45-degree field of view — 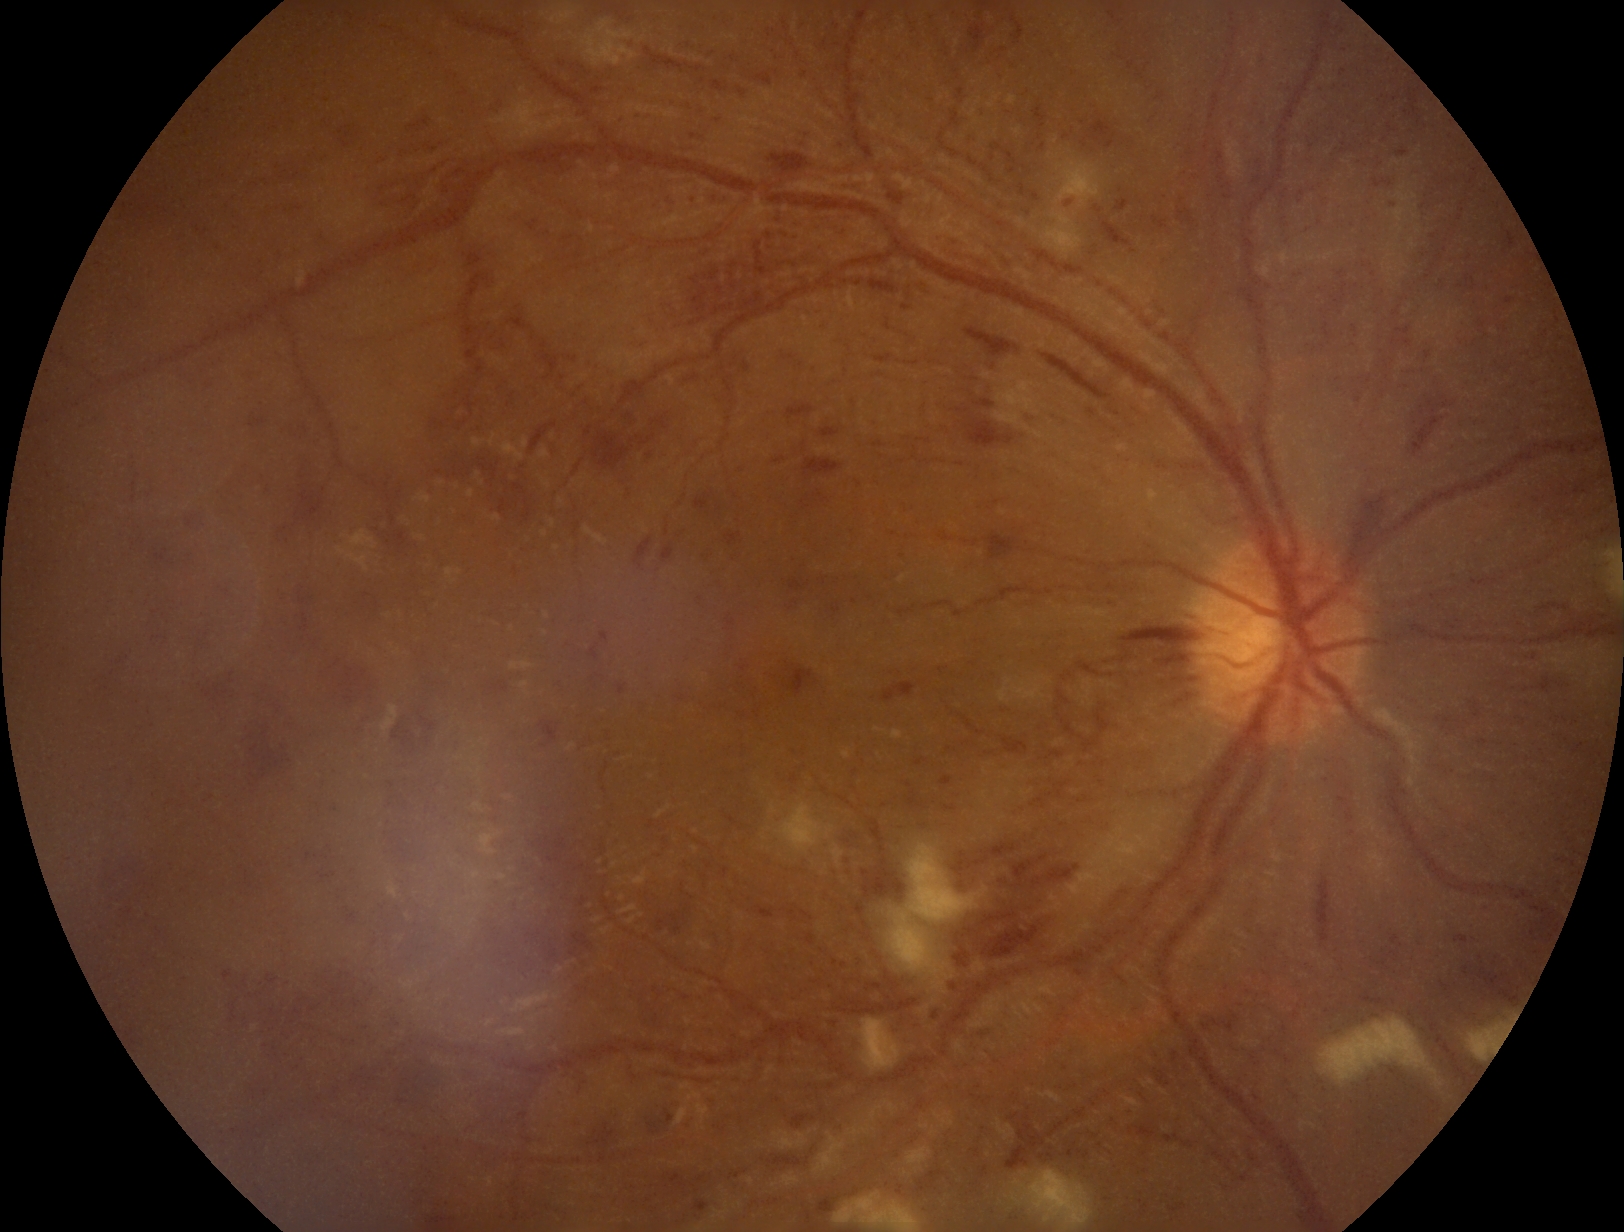

Diabetic retinopathy: 3/4.